DR severity per modified Davis staging. Posterior pole photograph.
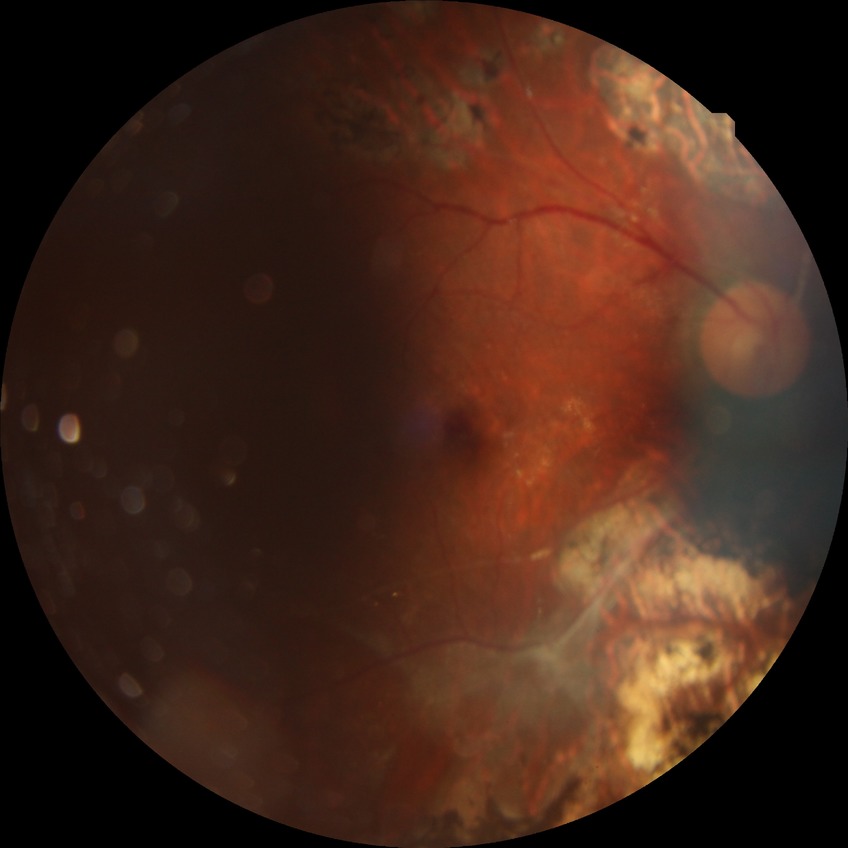 diabetic retinopathy (DR) = proliferative diabetic retinopathy (PDR)